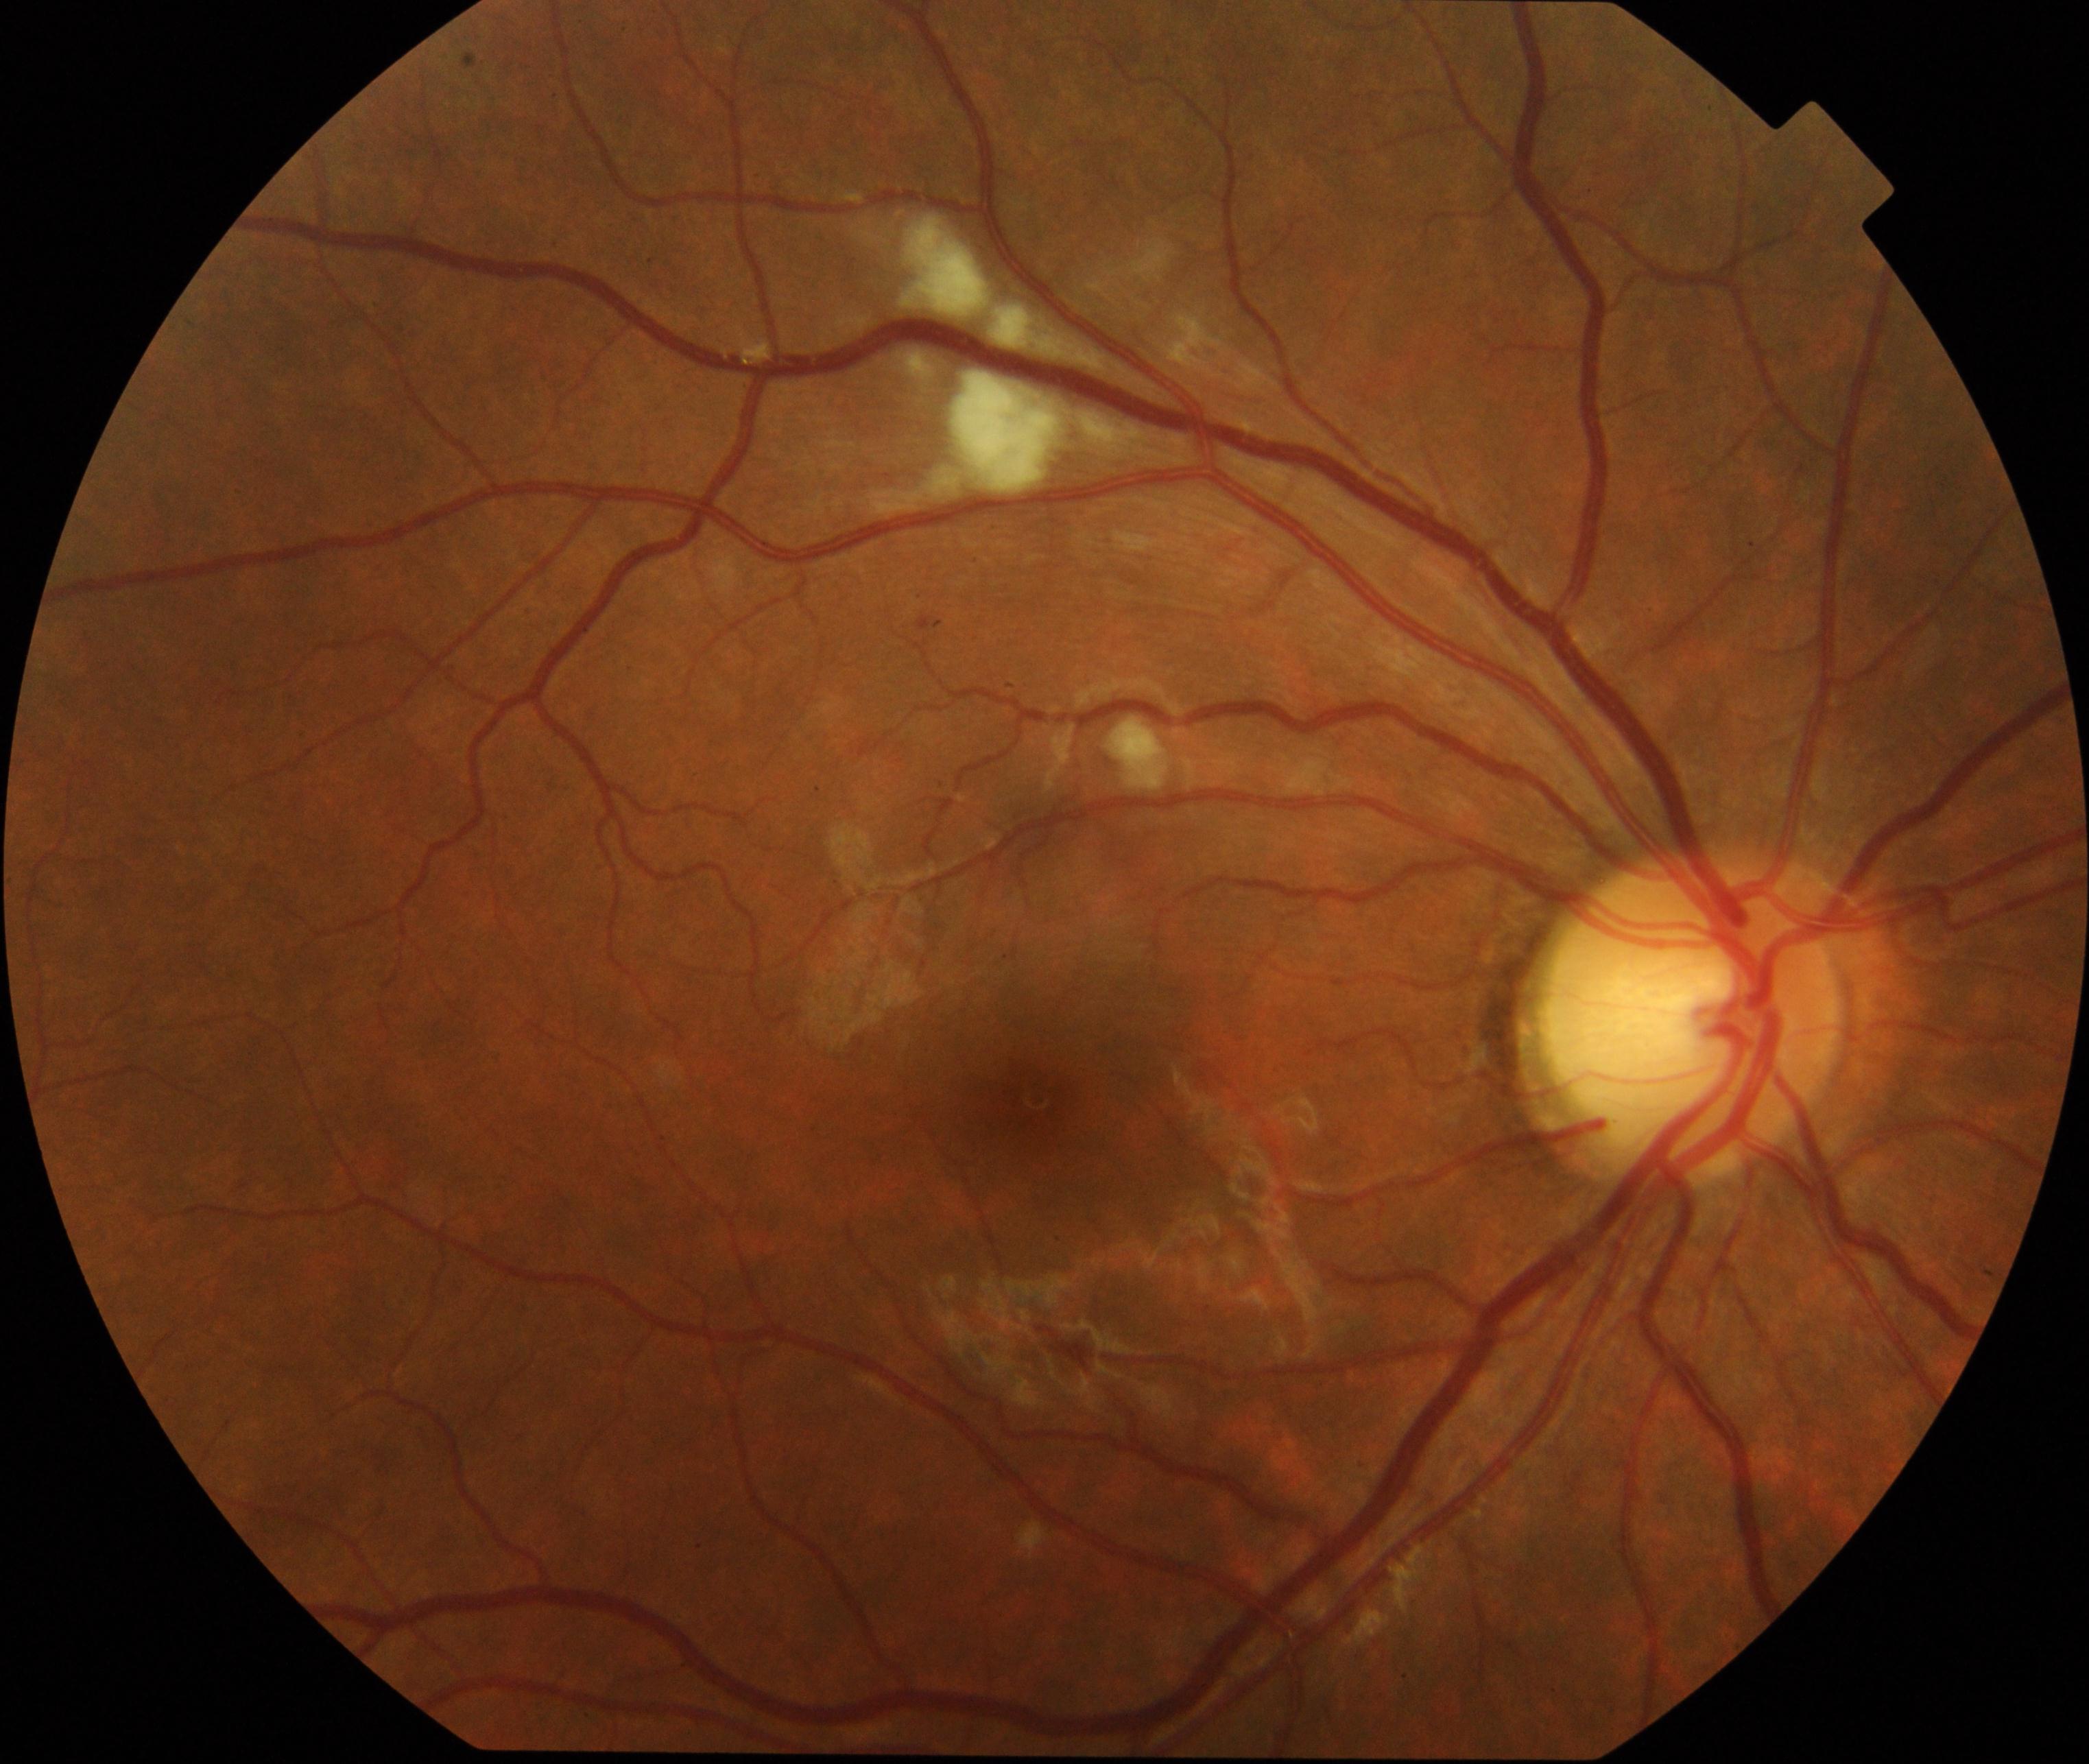
Consistent with cotton-wool spots.